2102x1736:
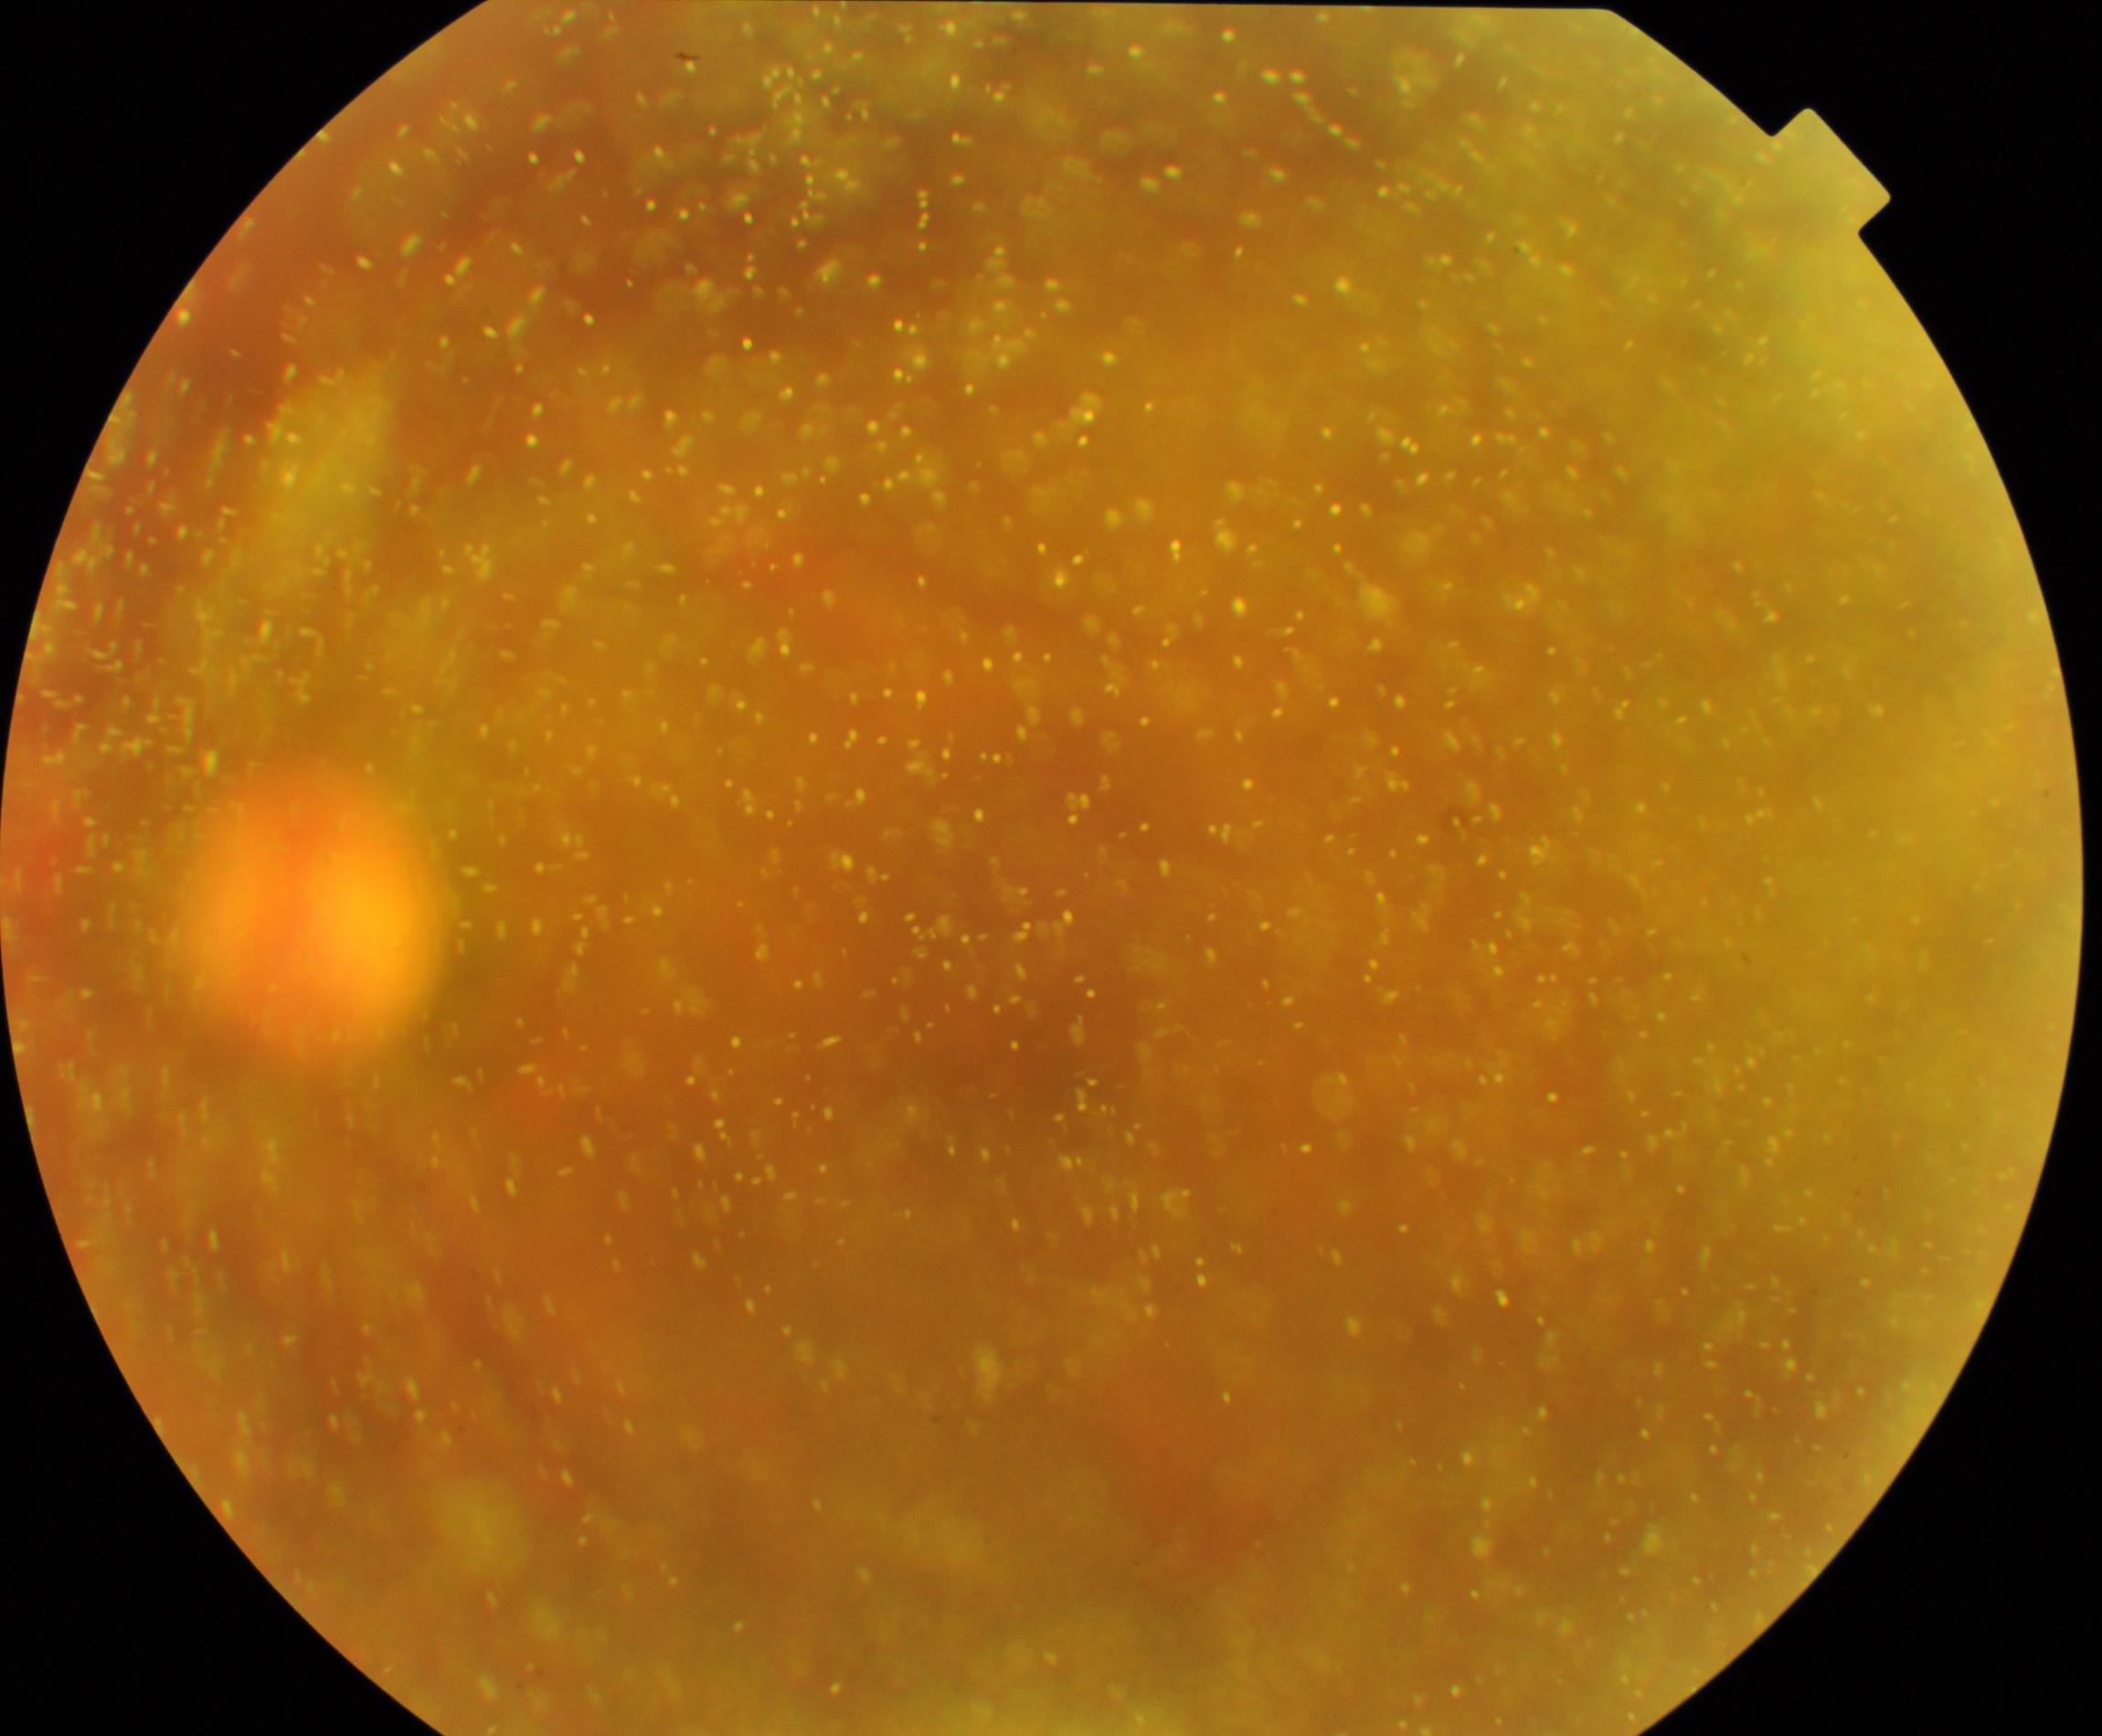
Retinal fundus photograph demonstrating vitreous particles.